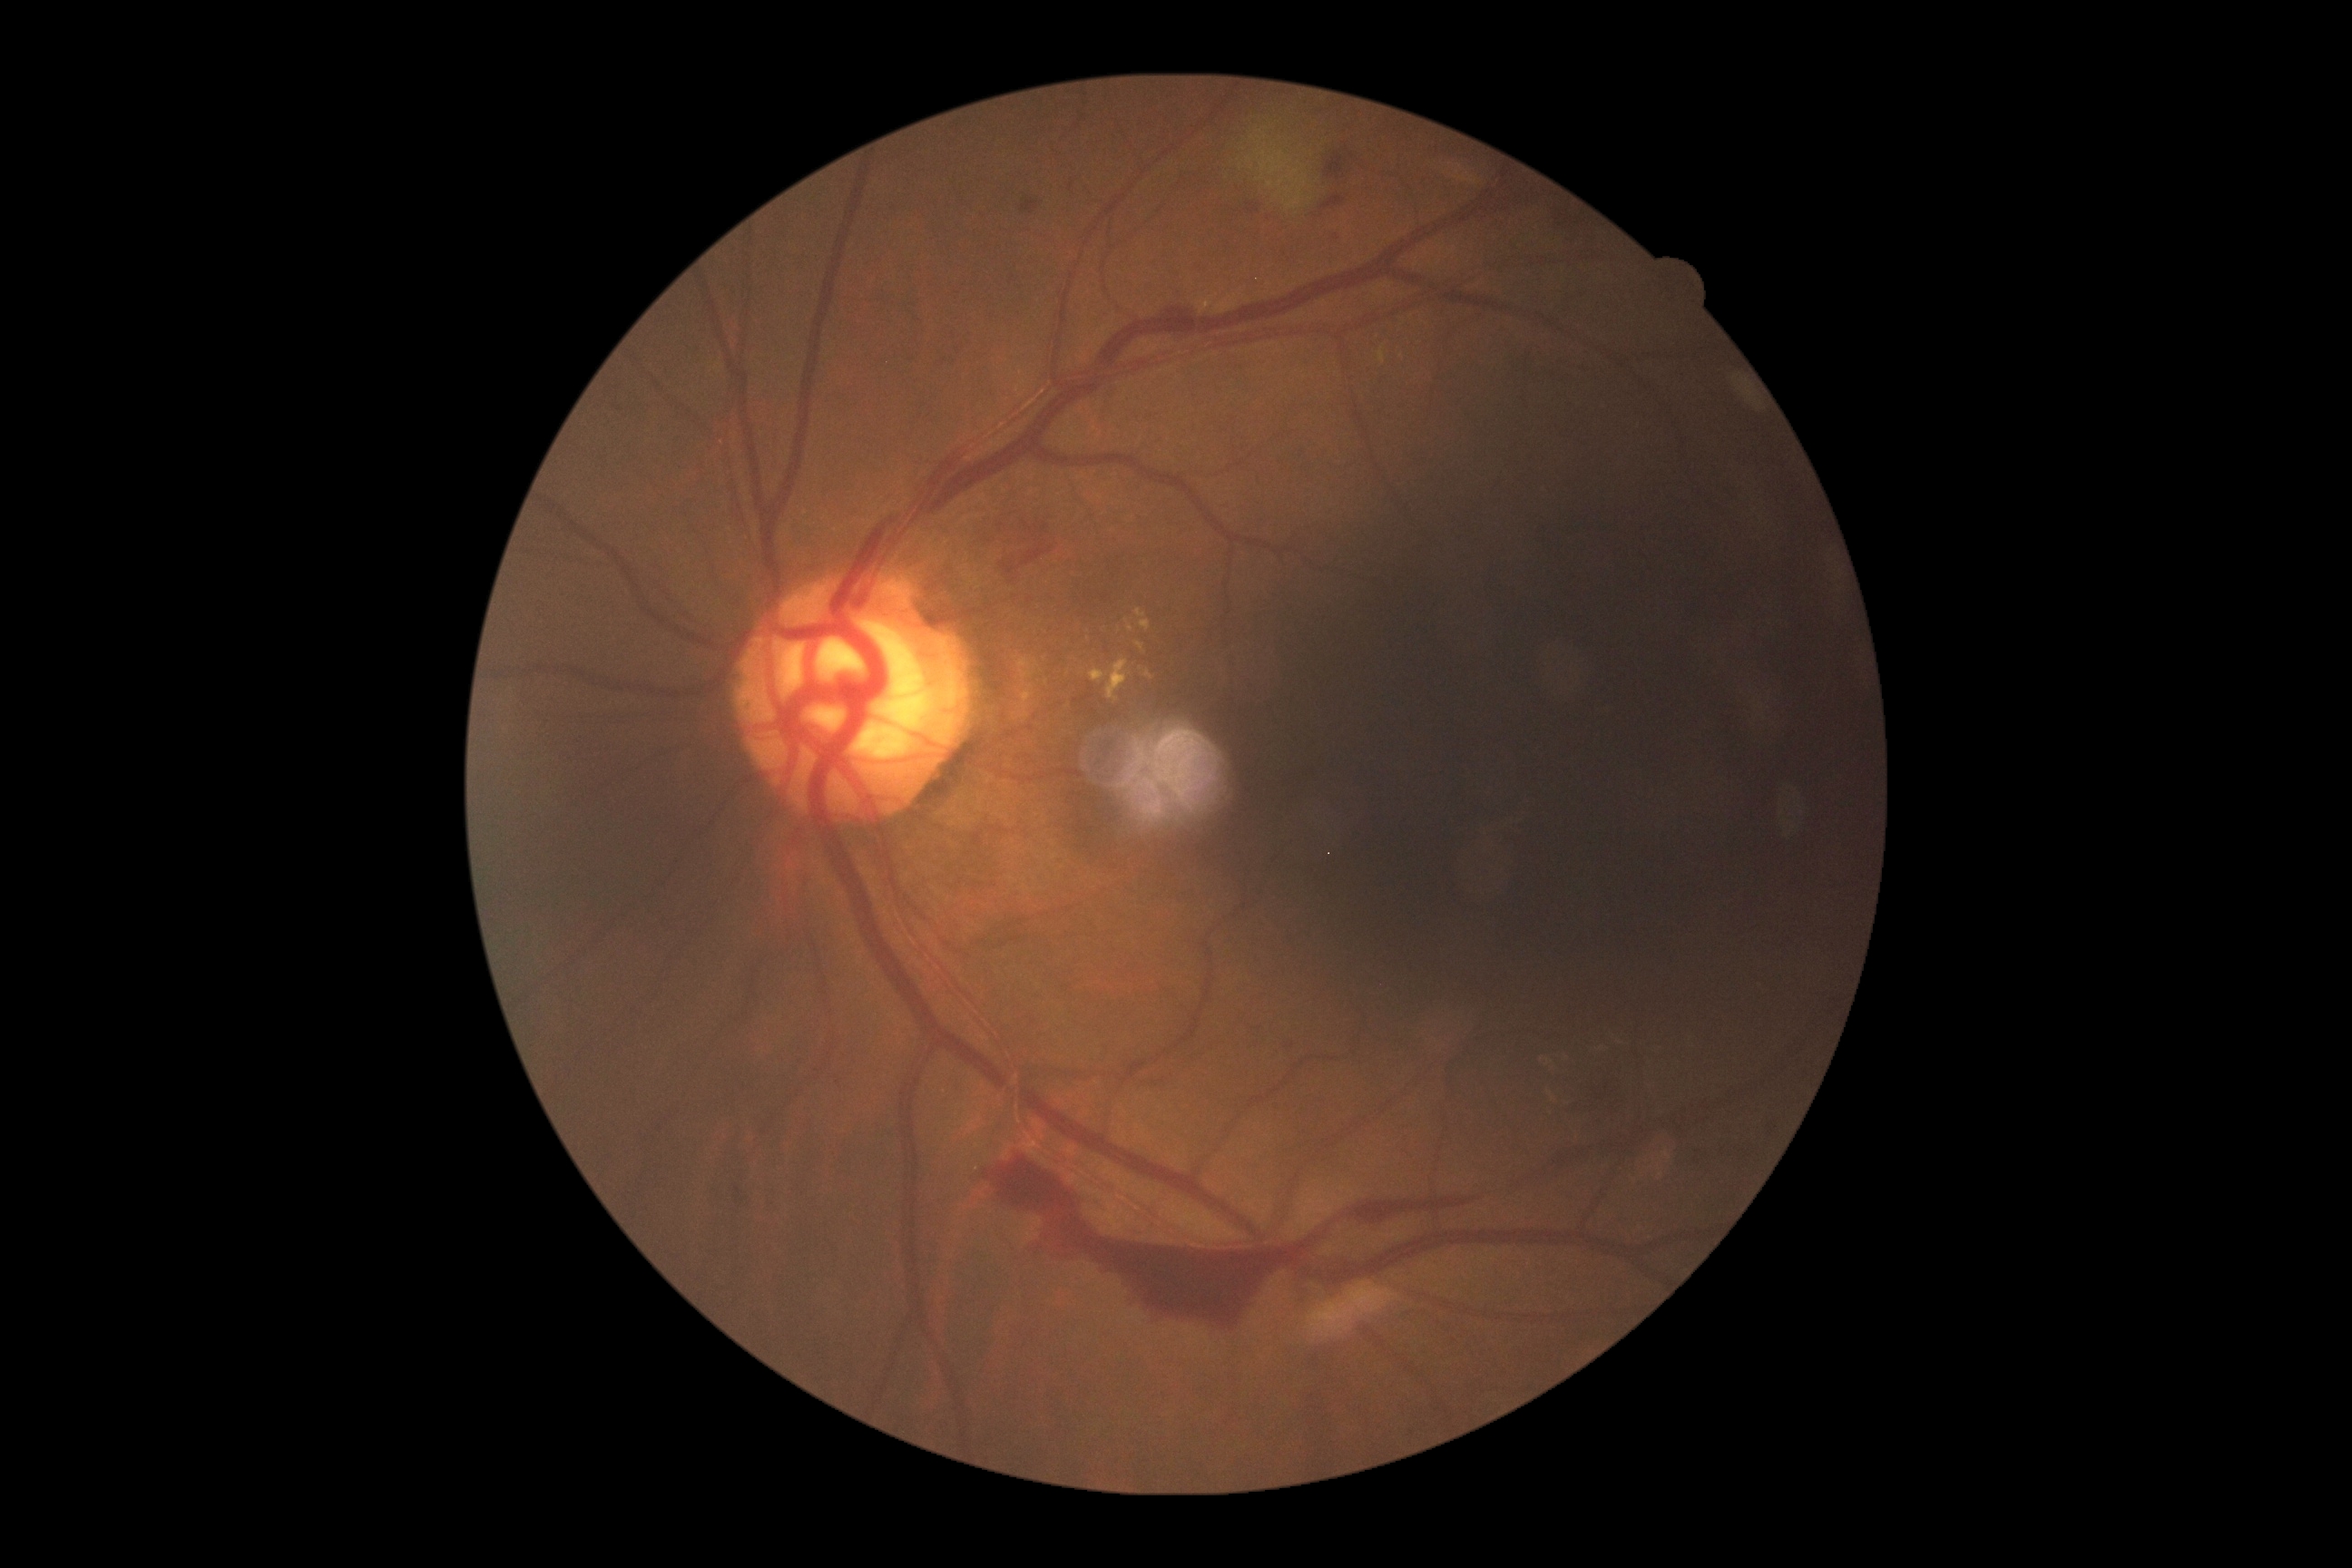
DR is proliferative diabetic retinopathy (grade 4).